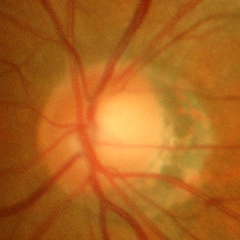

No evidence of glaucoma.